IOP: 16 mmHg. Axial length: 23.97 mm. Woman.
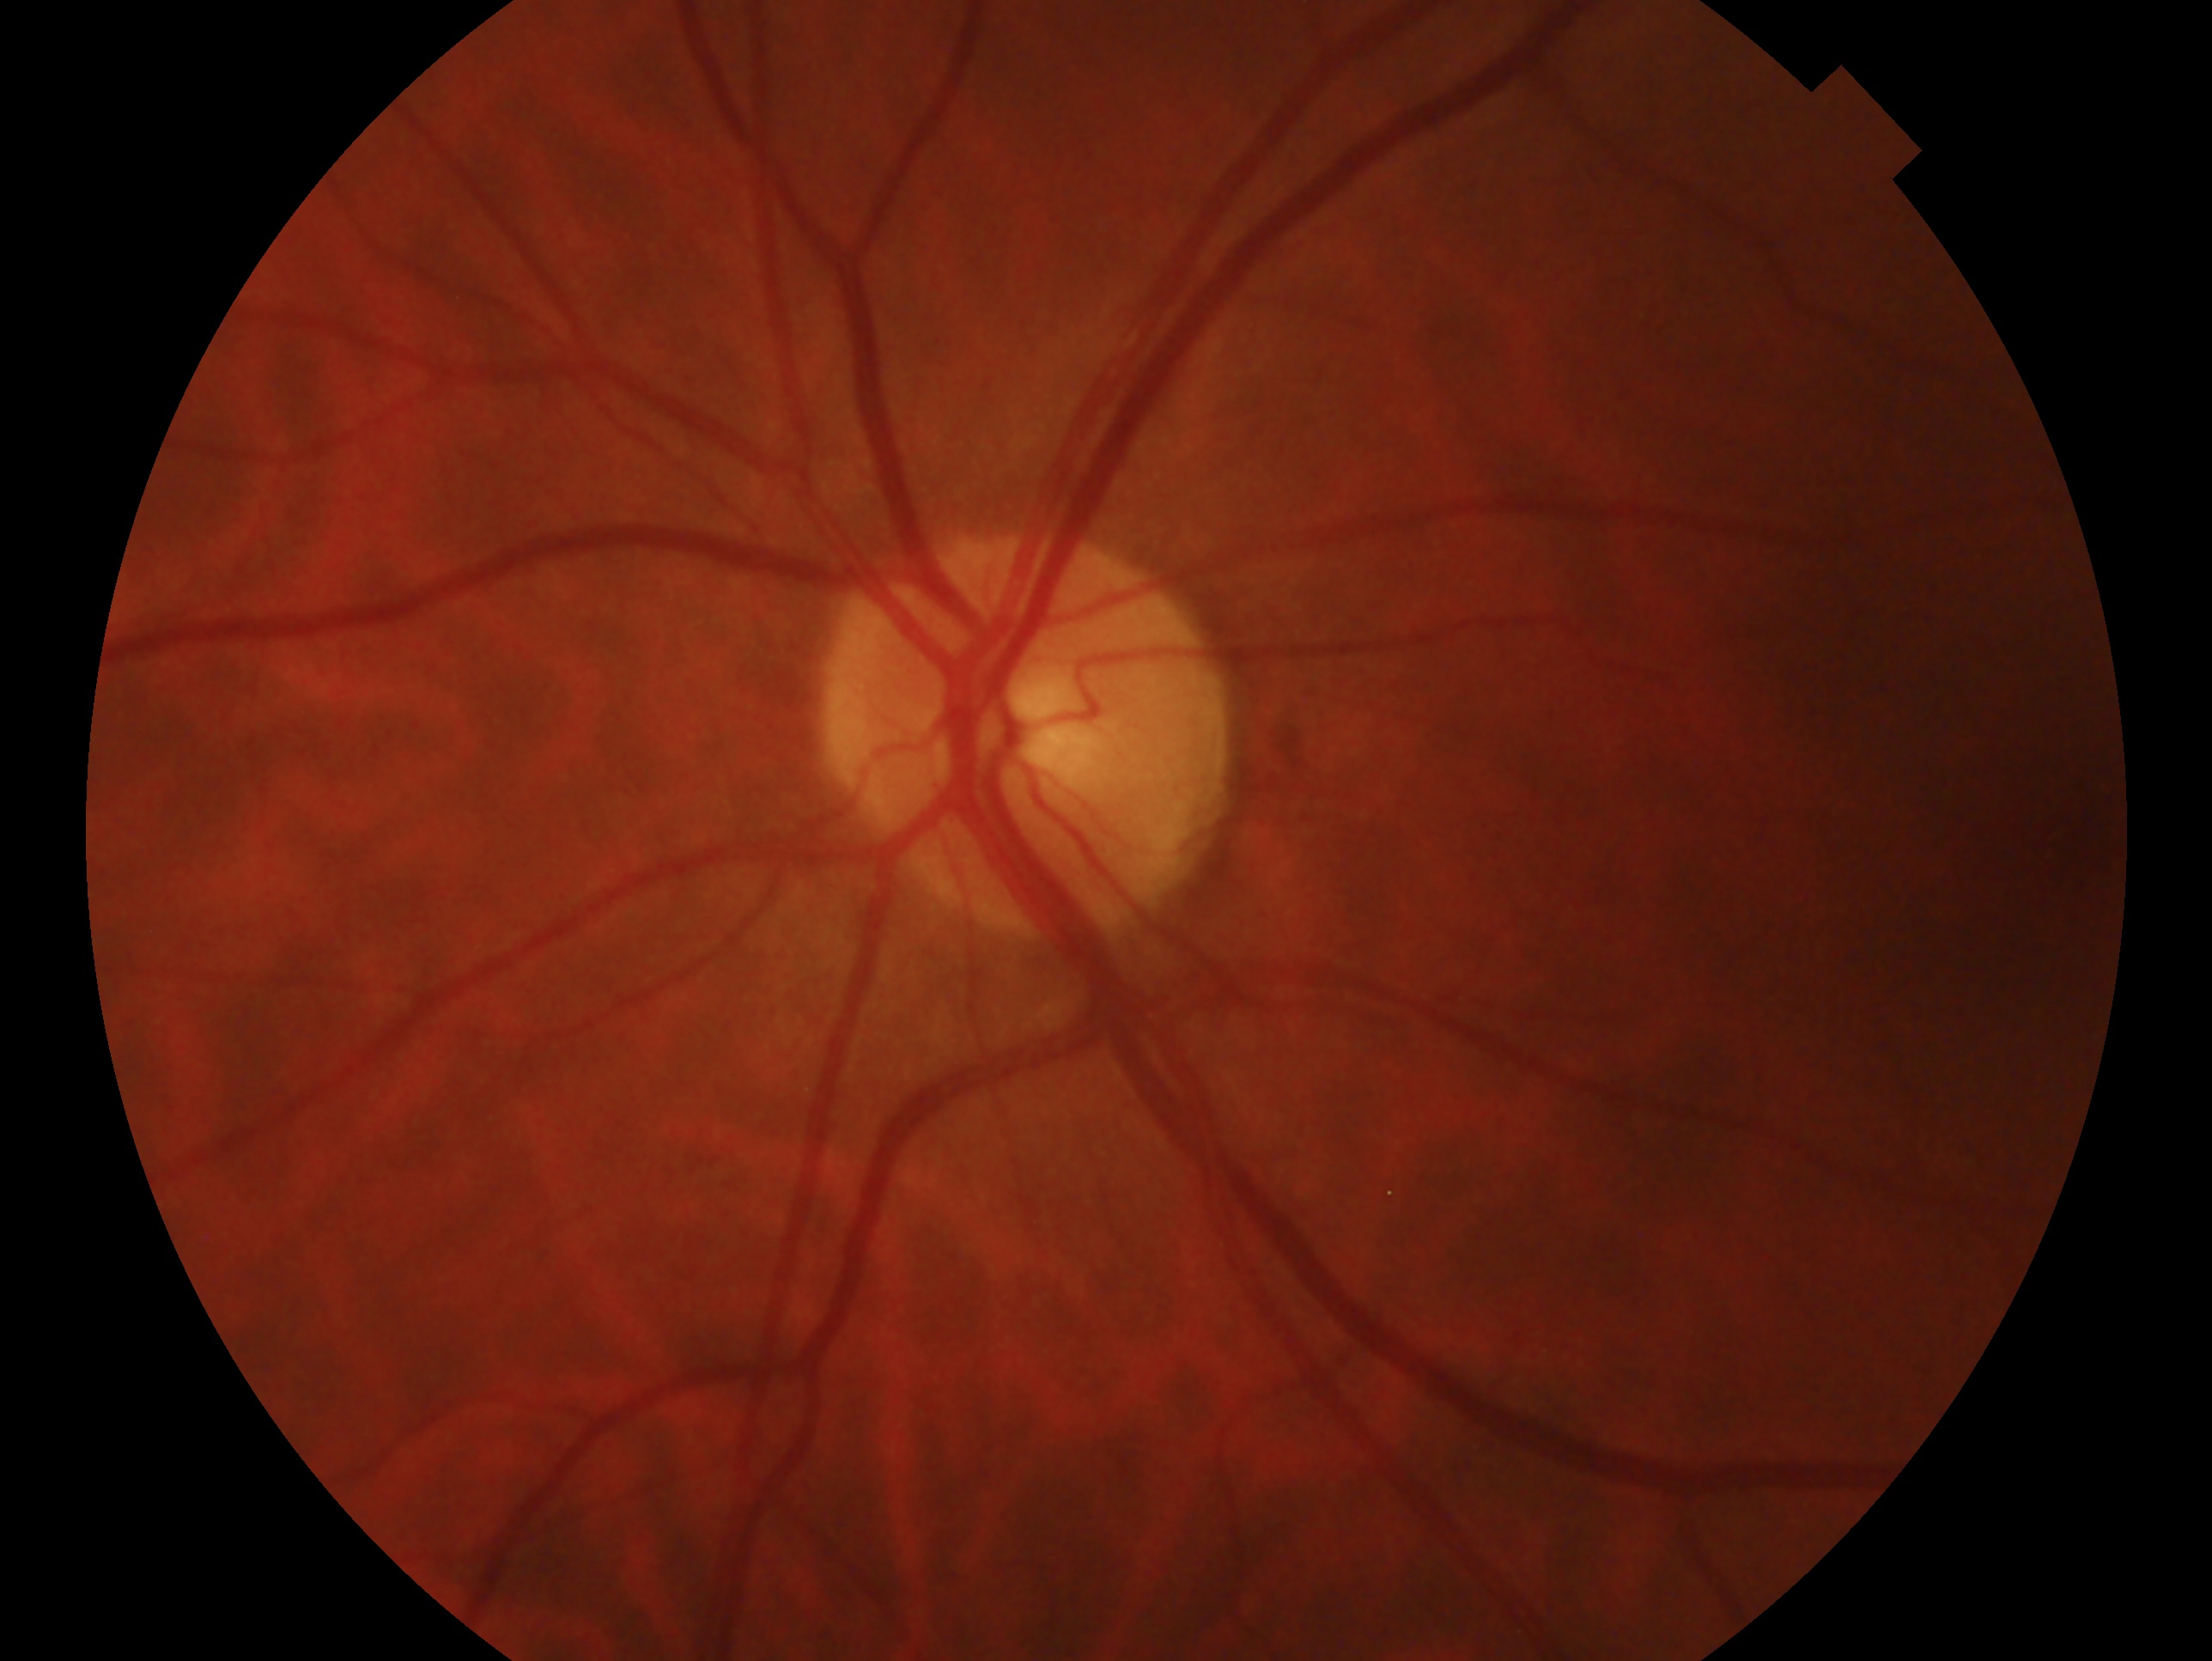 Diagnosis: no glaucomatous findings.
This is the OS.